Fundus photo:
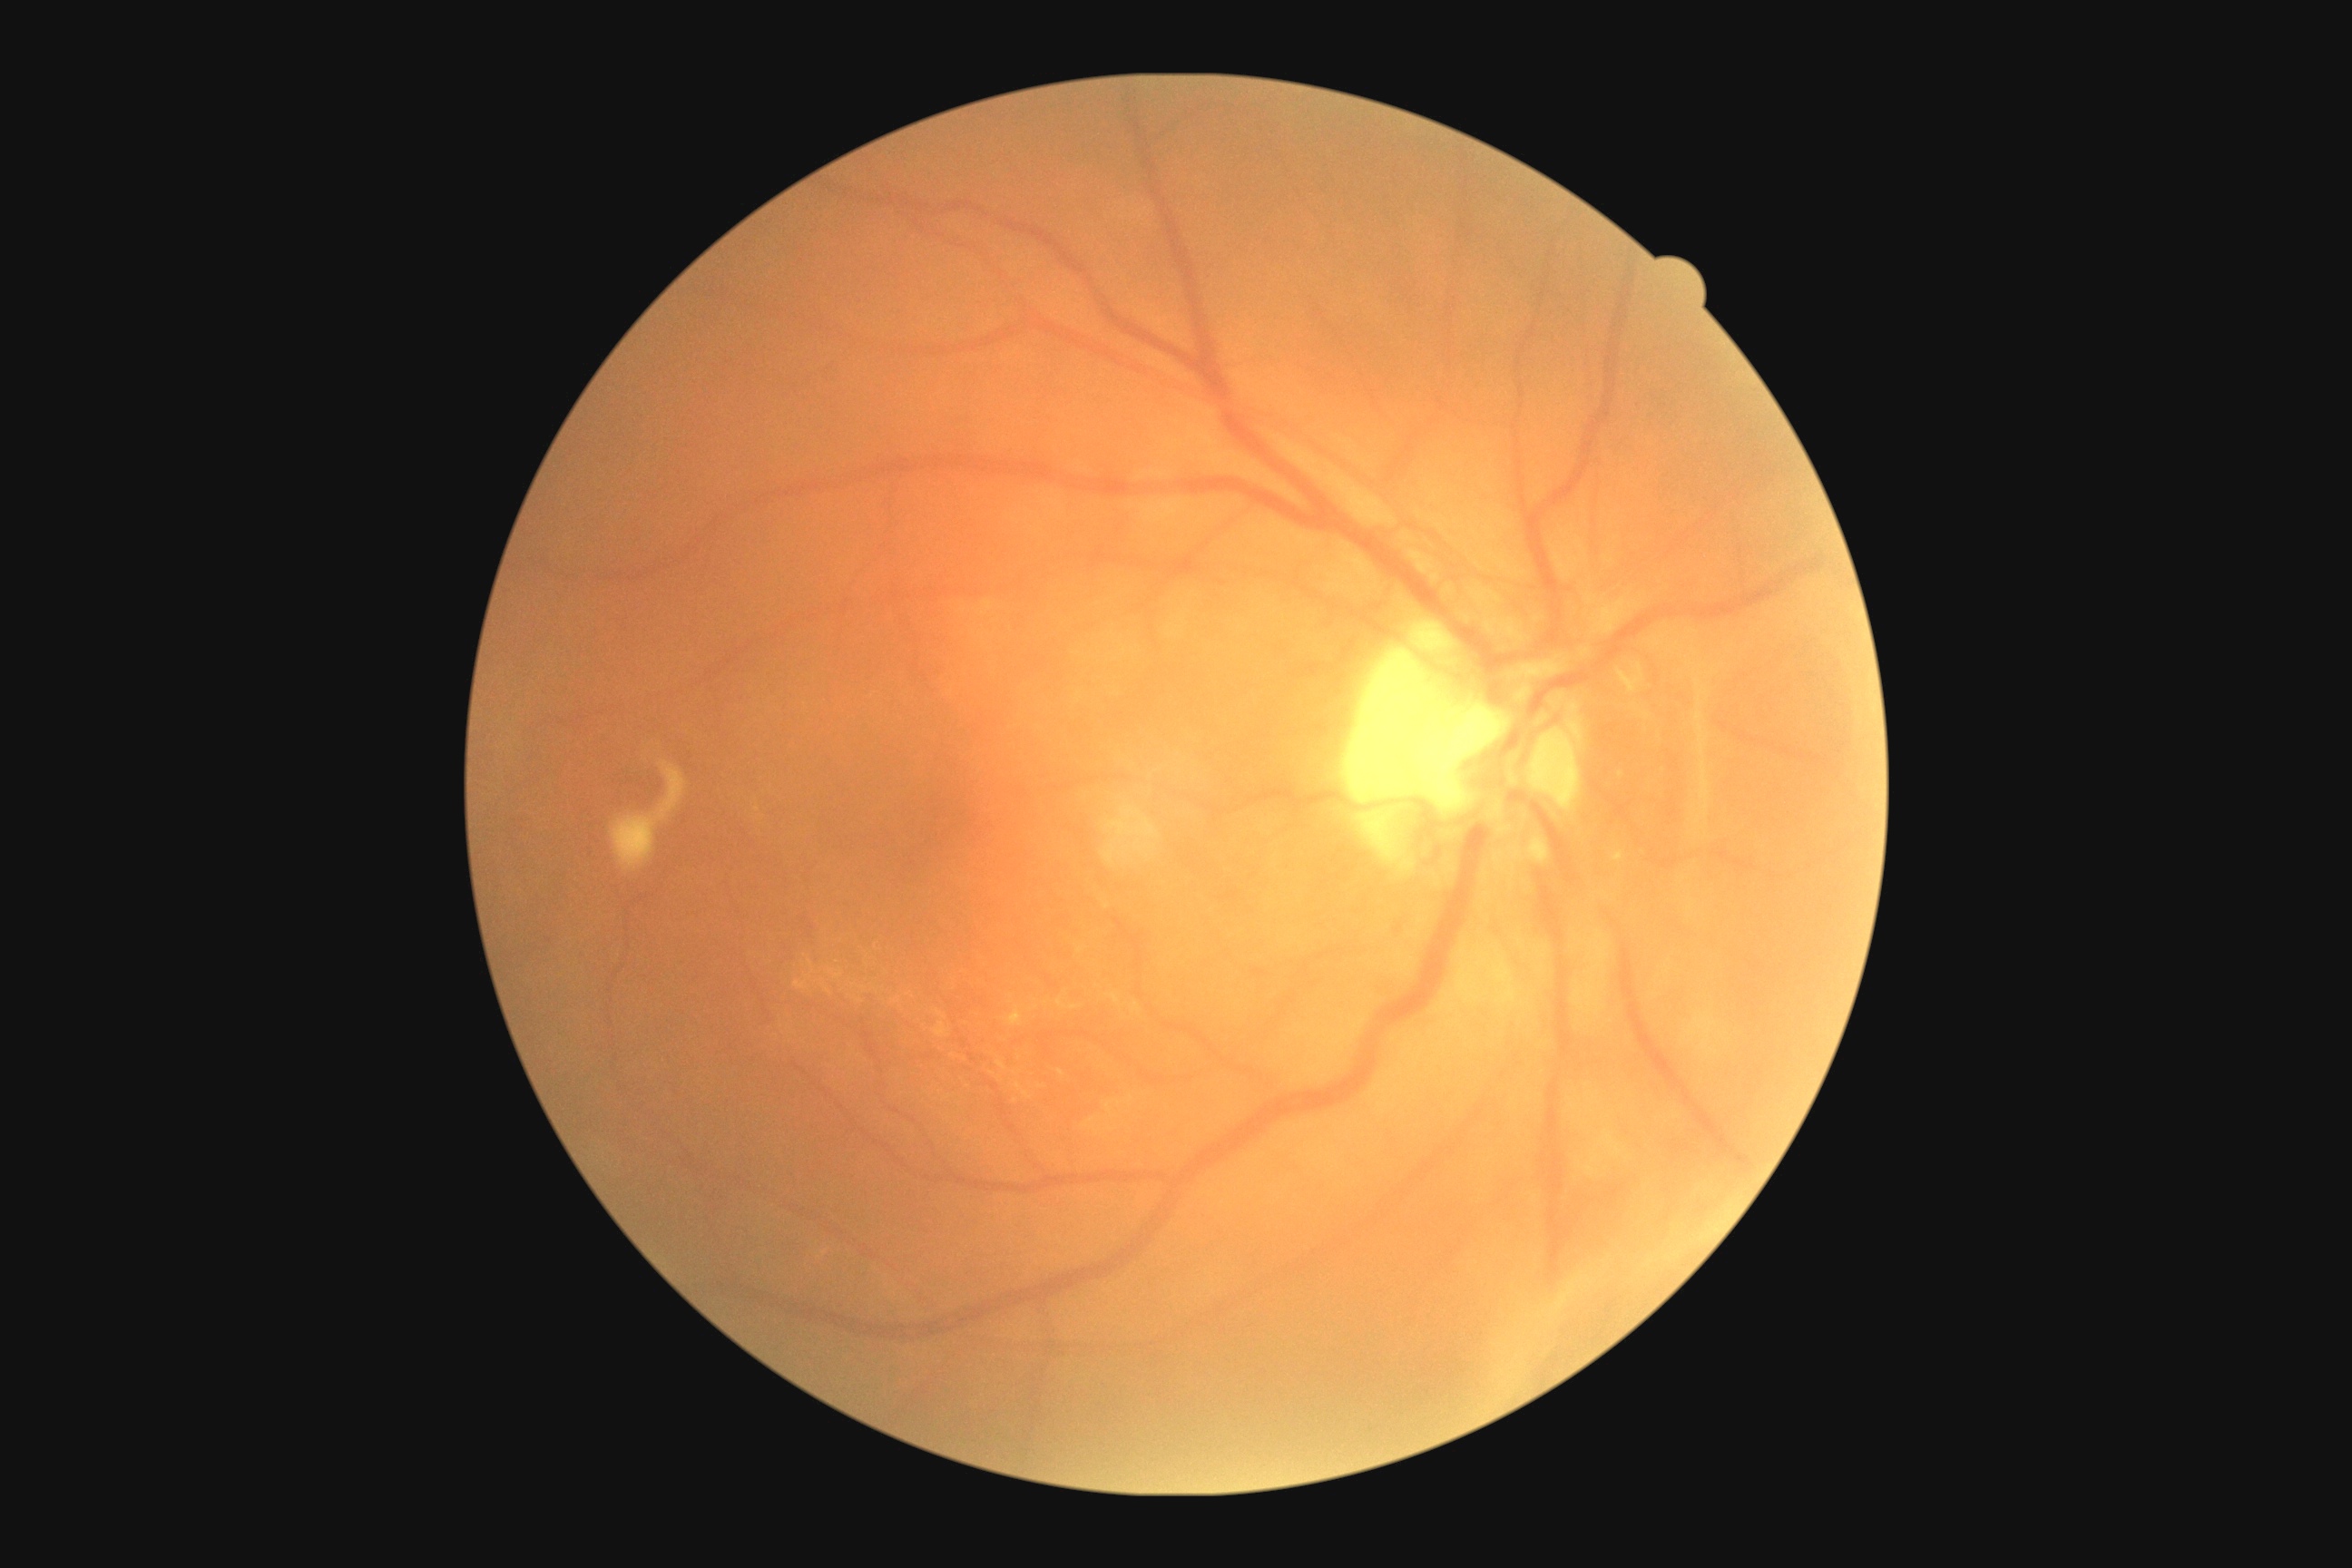 Findings:
– diabetic retinopathy (DR): grade 4